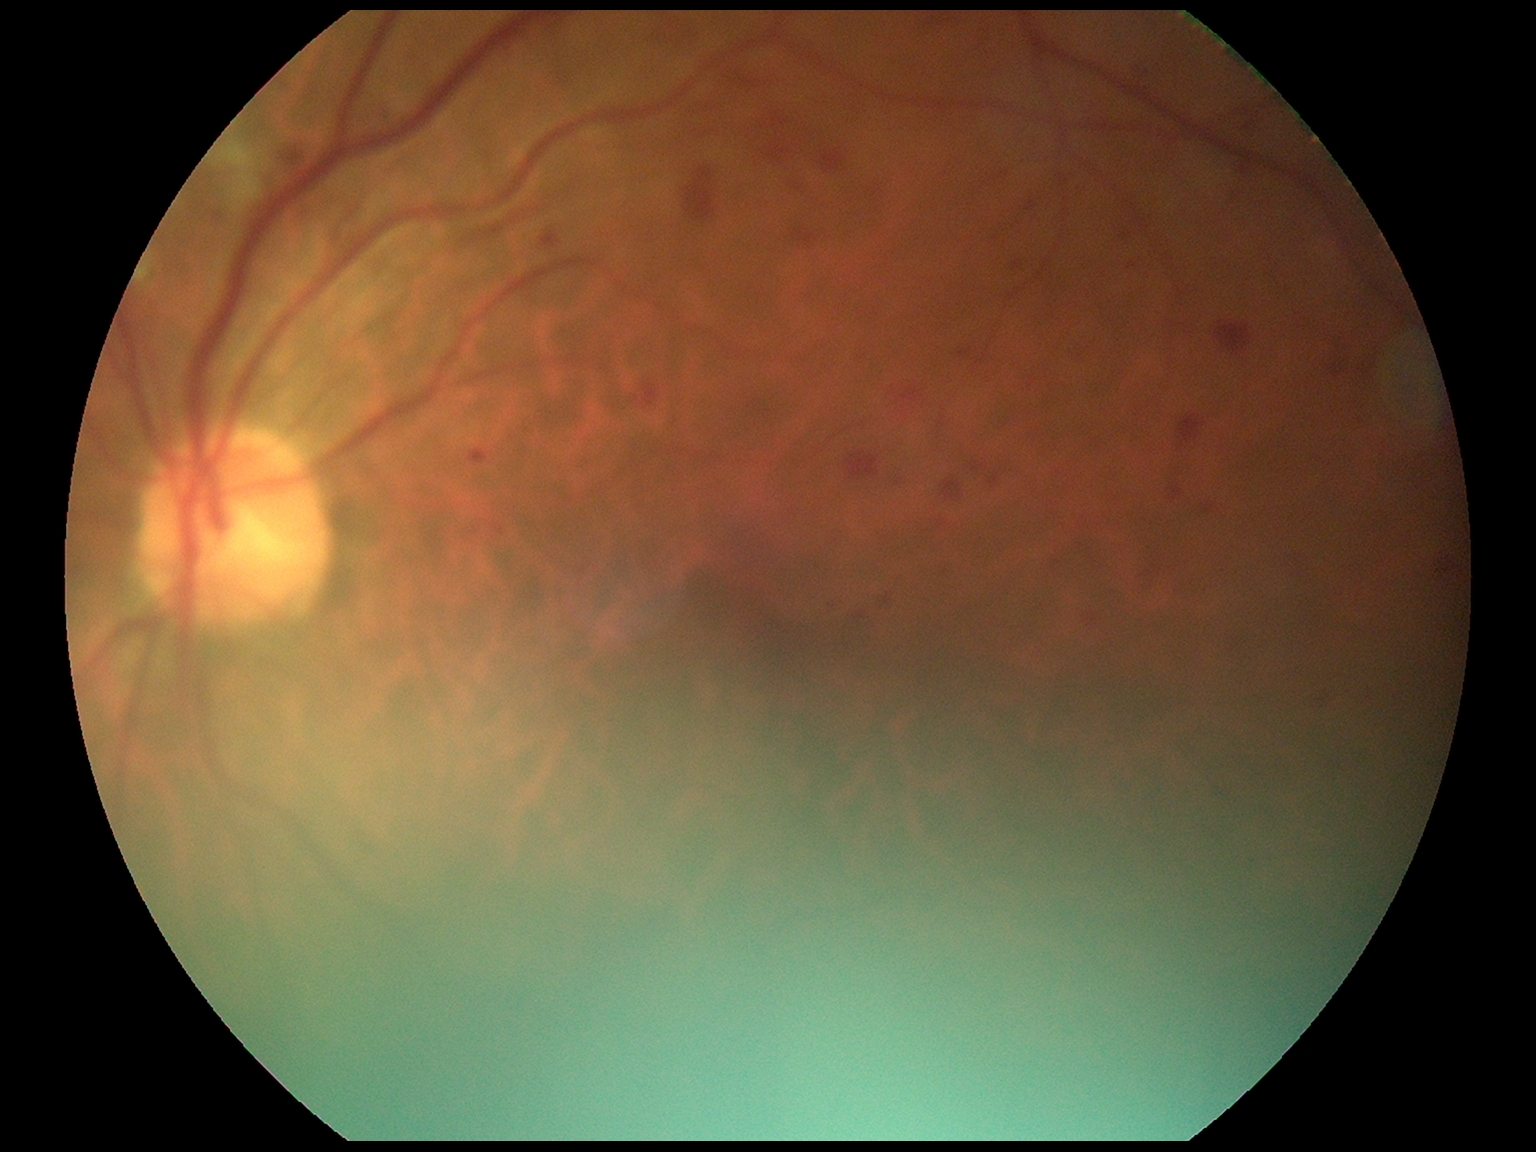

  dr_grade: grade 2 (moderate NPDR)